Retinal fundus photograph, FOV: 45 degrees
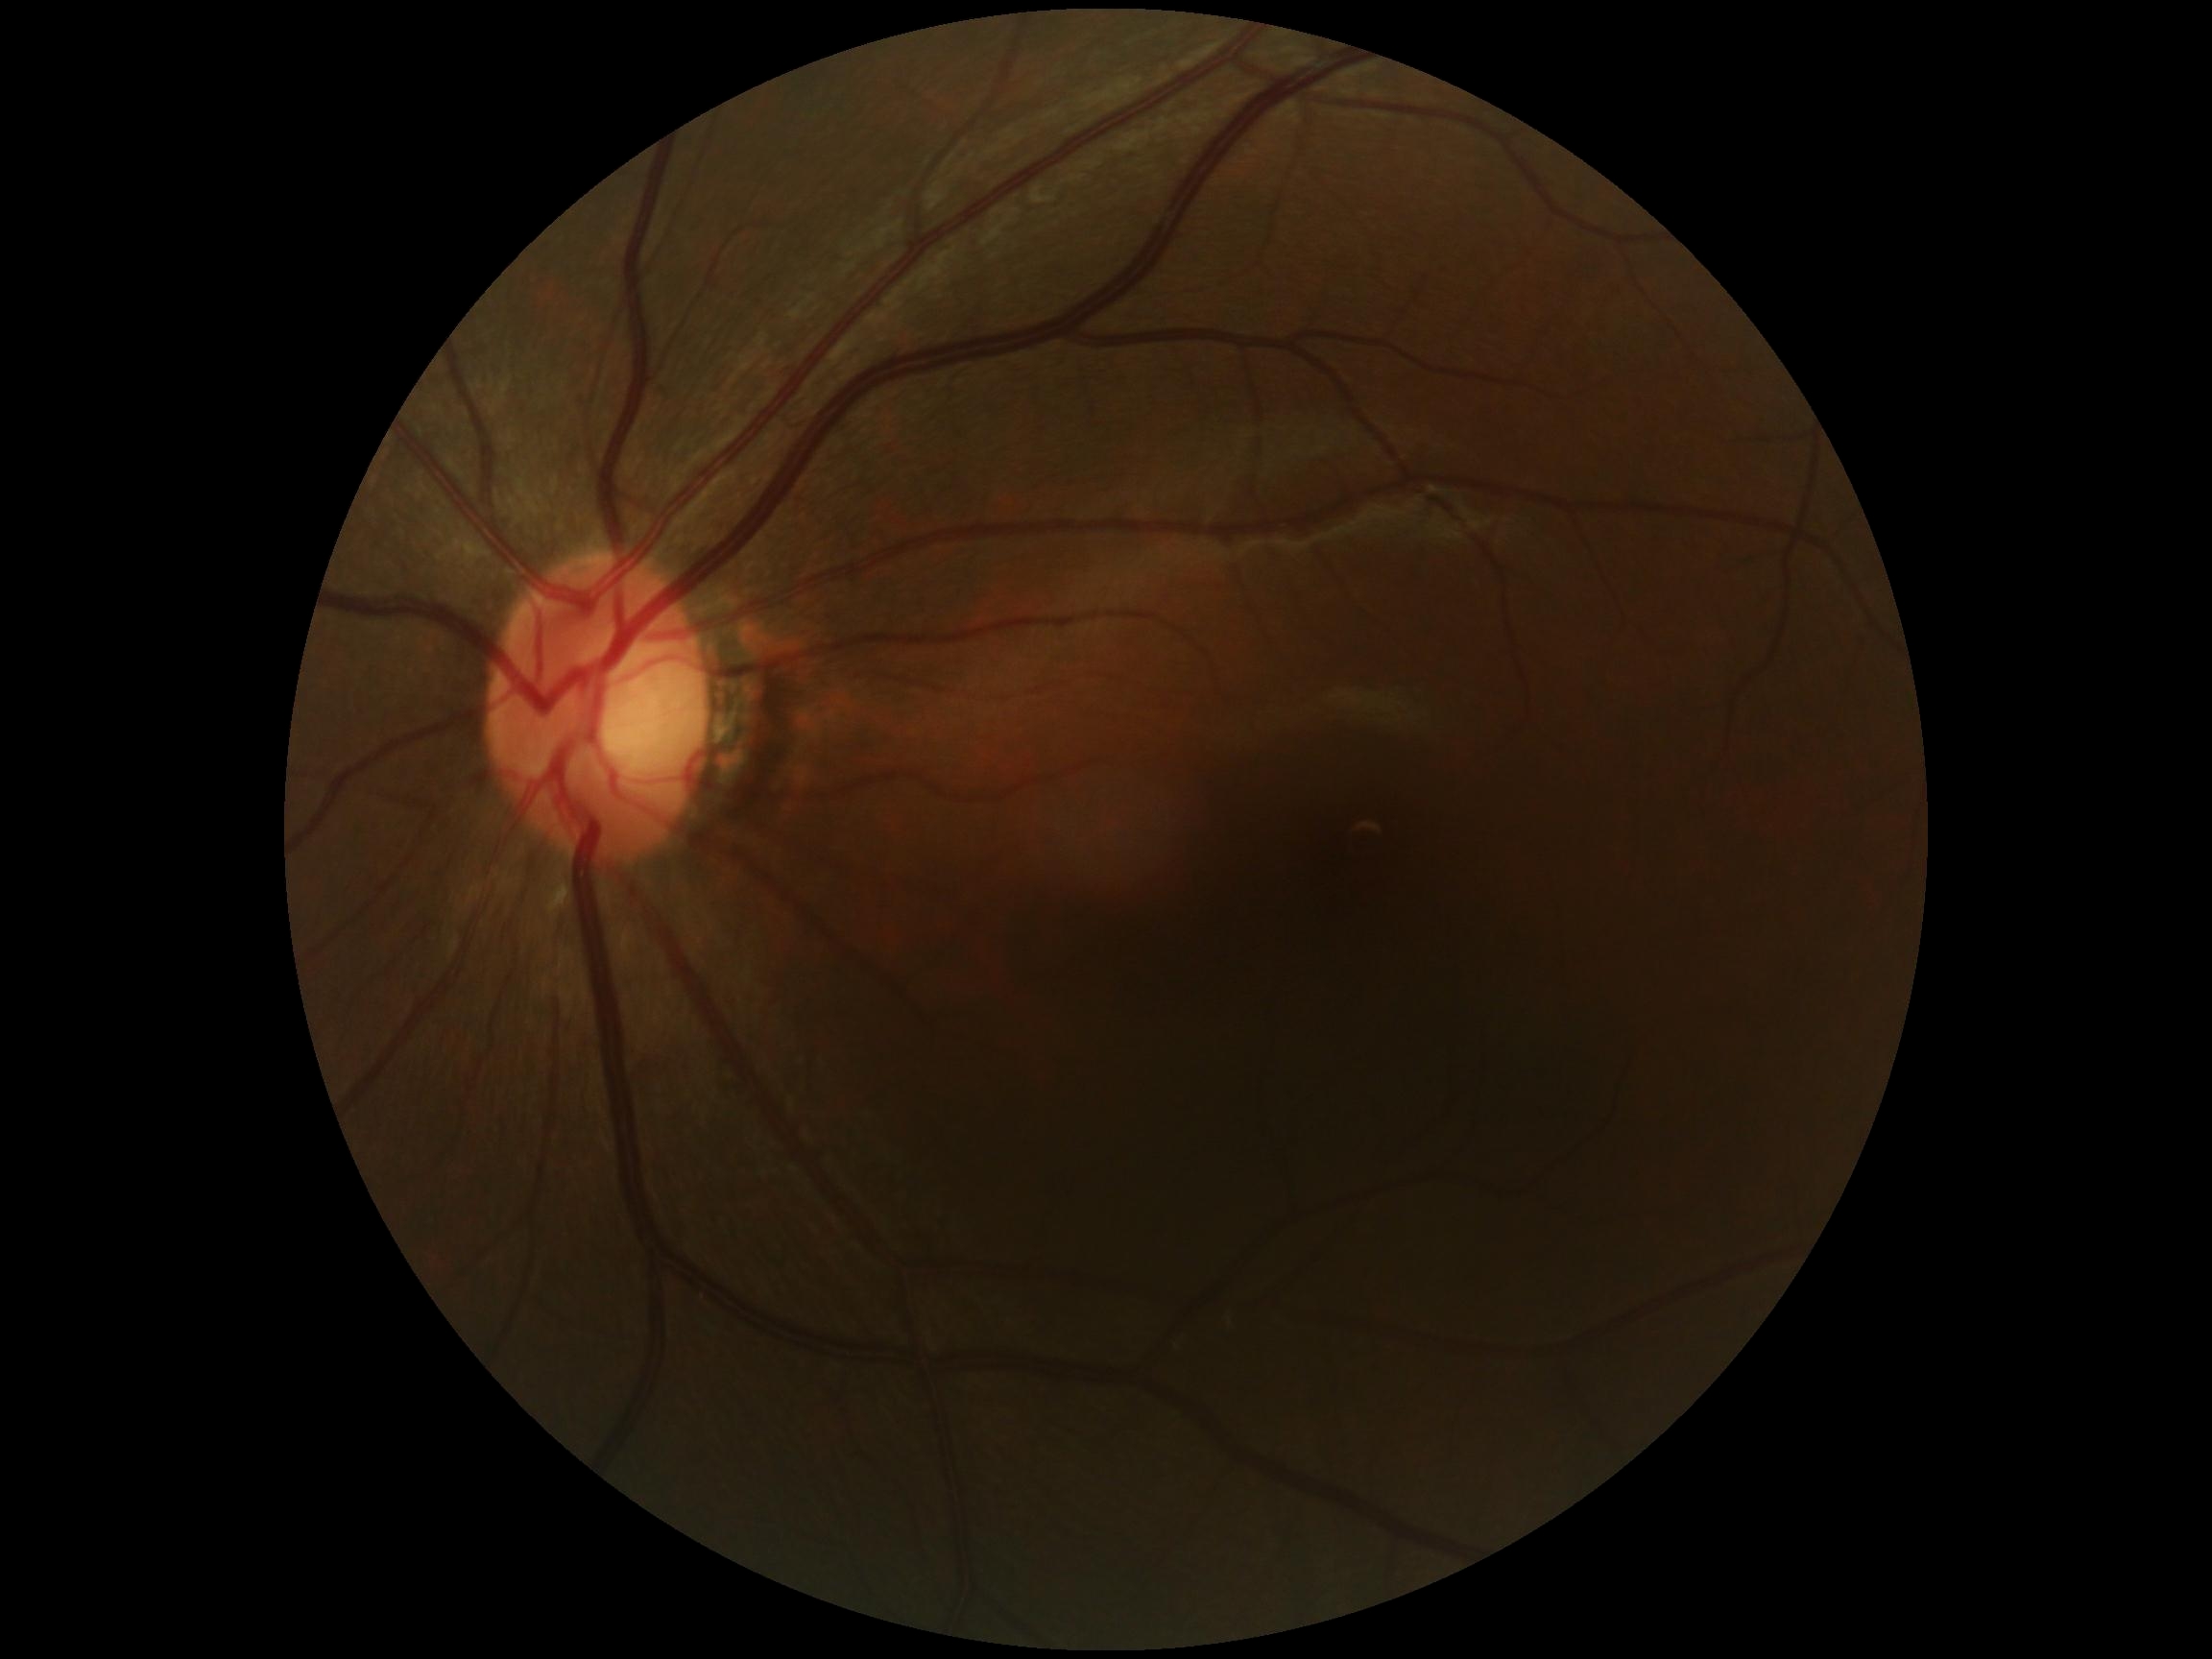

No DR findings.
DR severity is 0.